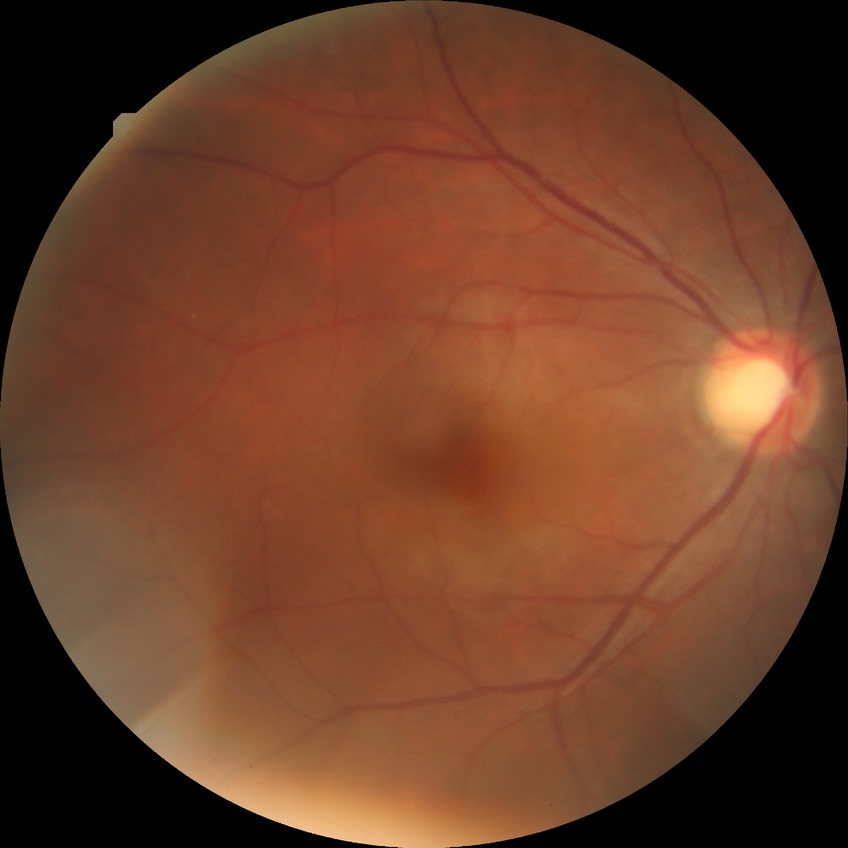
Davis stage is NDR.
No apparent diabetic retinopathy.